2048 by 1536 pixels.
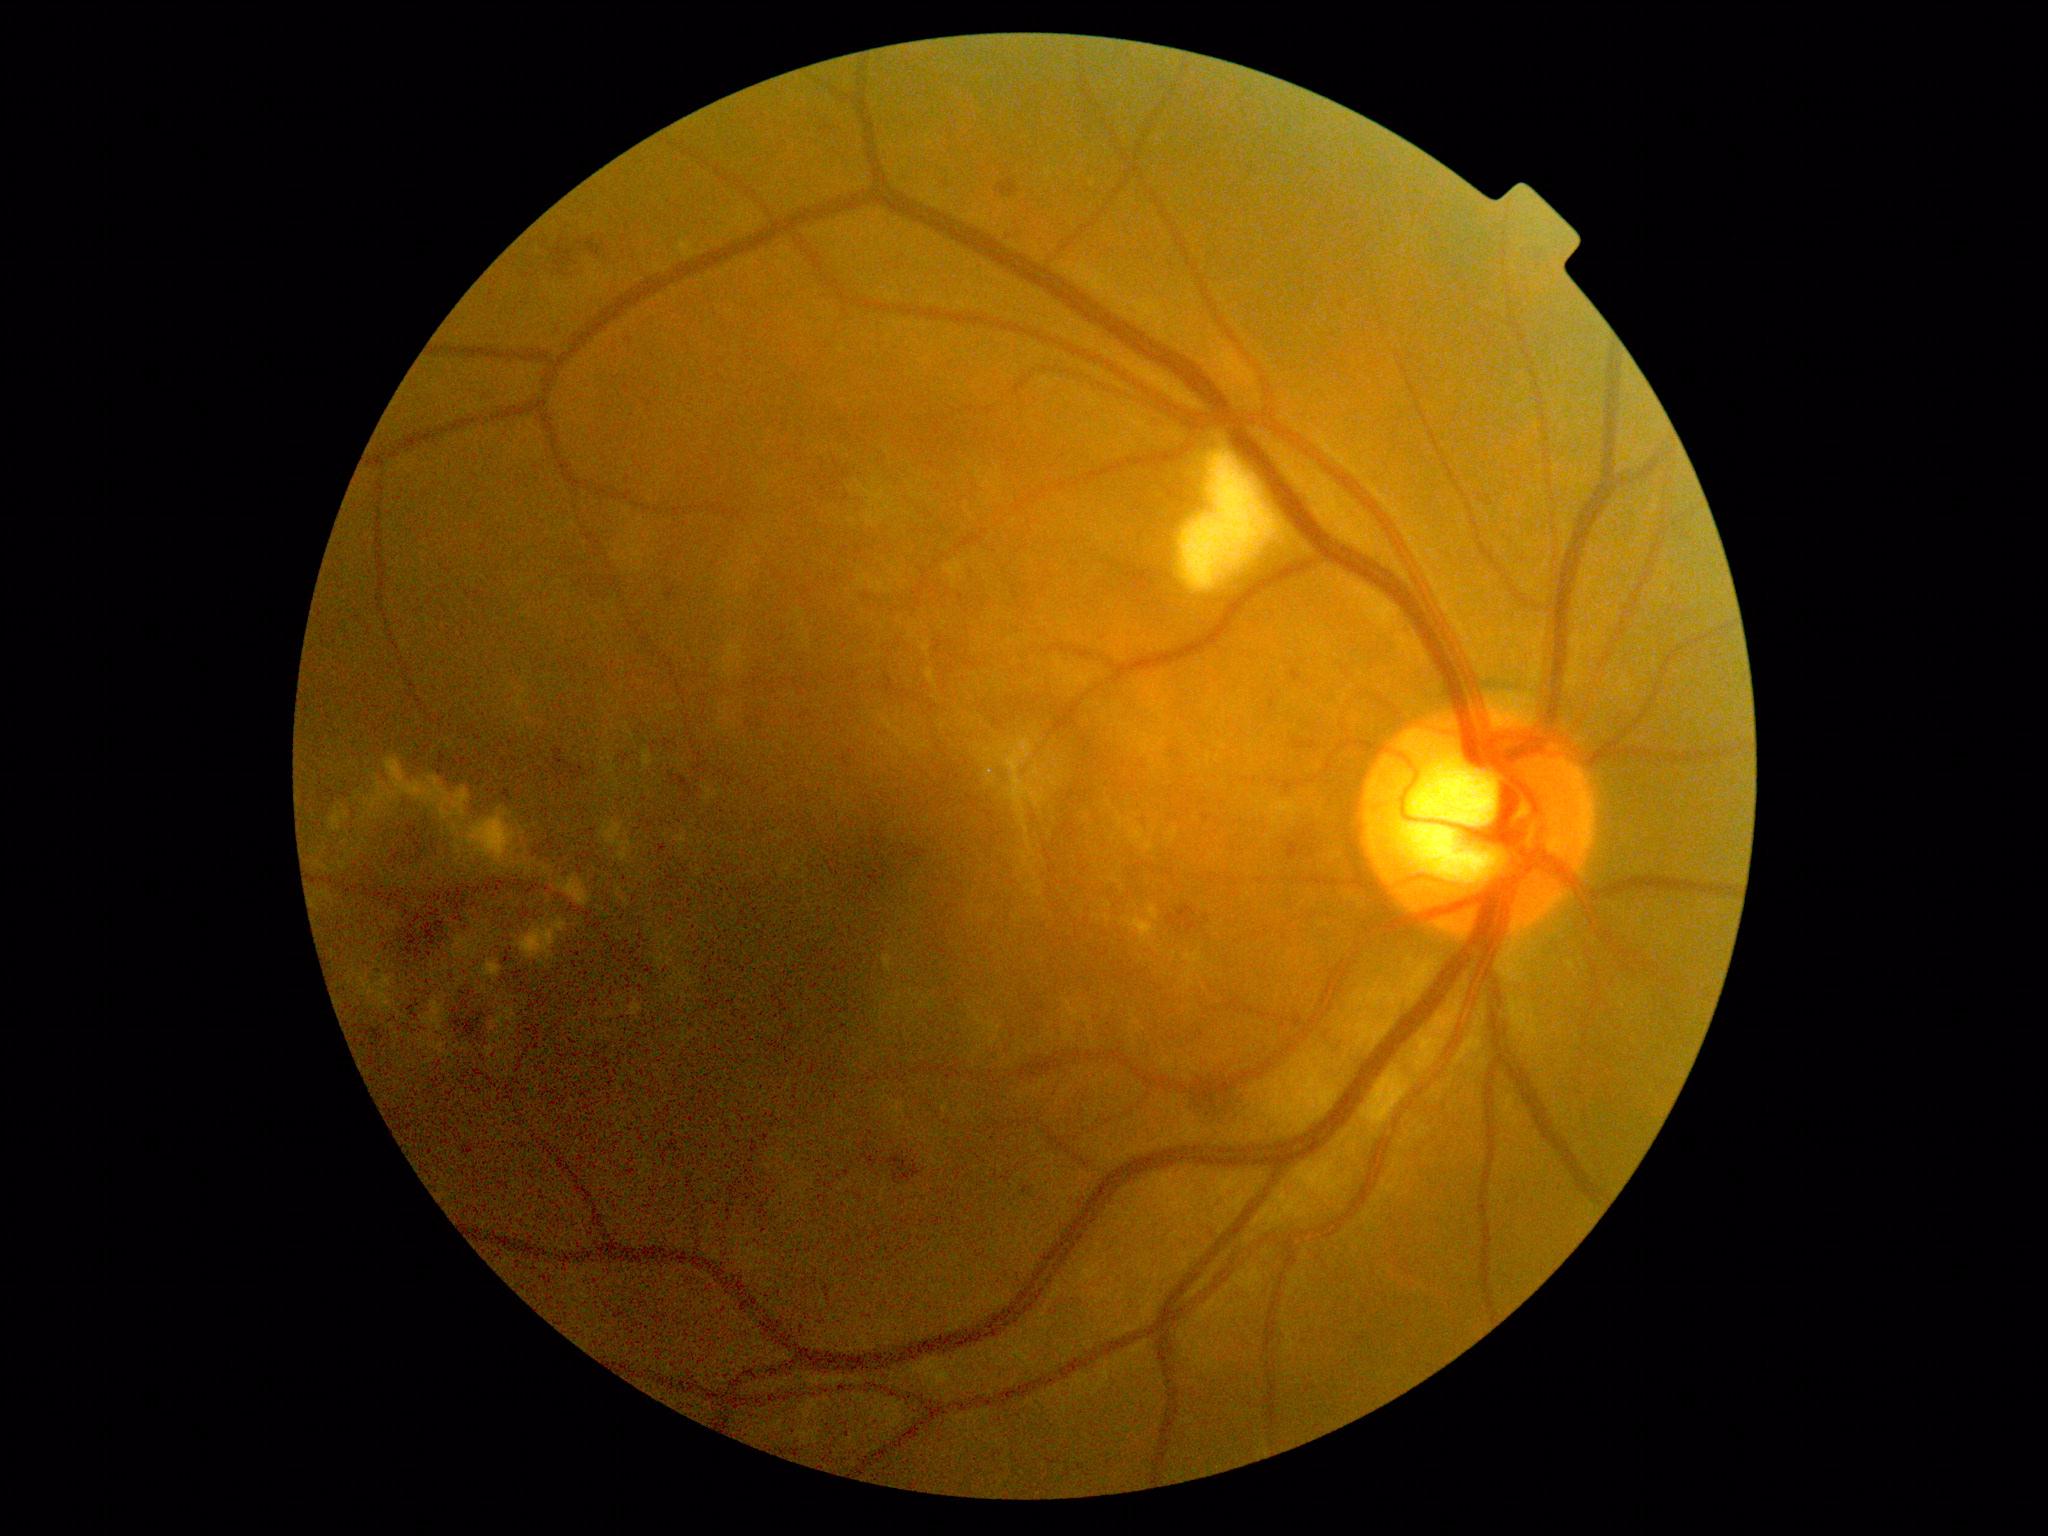 DR: 2.